Wide-field contact fundus photograph of an infant · image size 640x480.
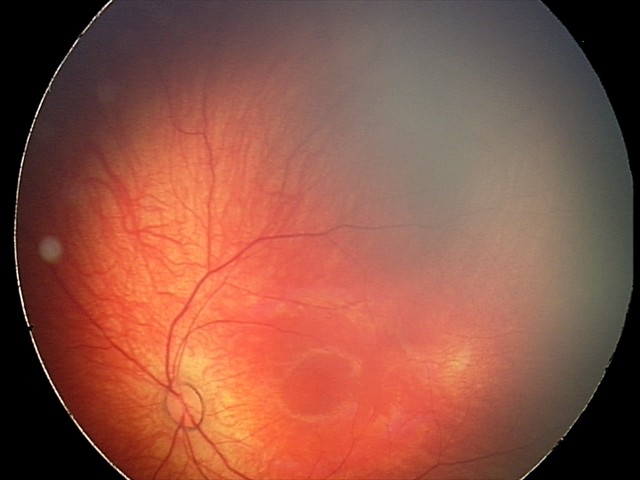 Q: What was the screening finding?
A: retinal hemorrhages